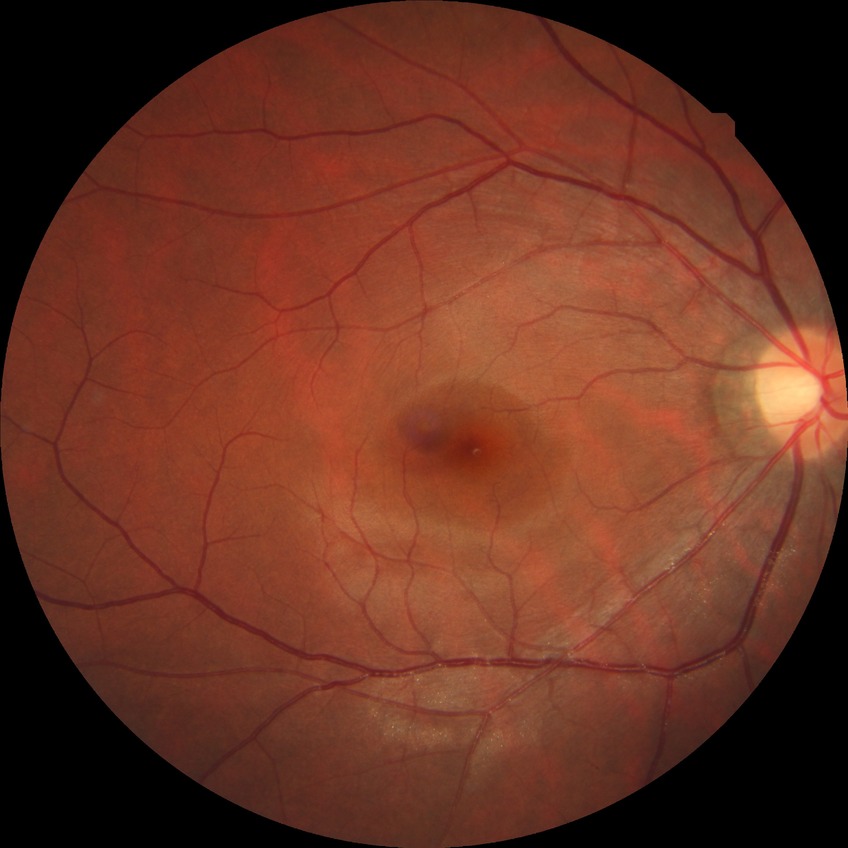 Diabetic retinopathy (DR): no diabetic retinopathy (NDR).